Camera: NIDEK AFC-230.
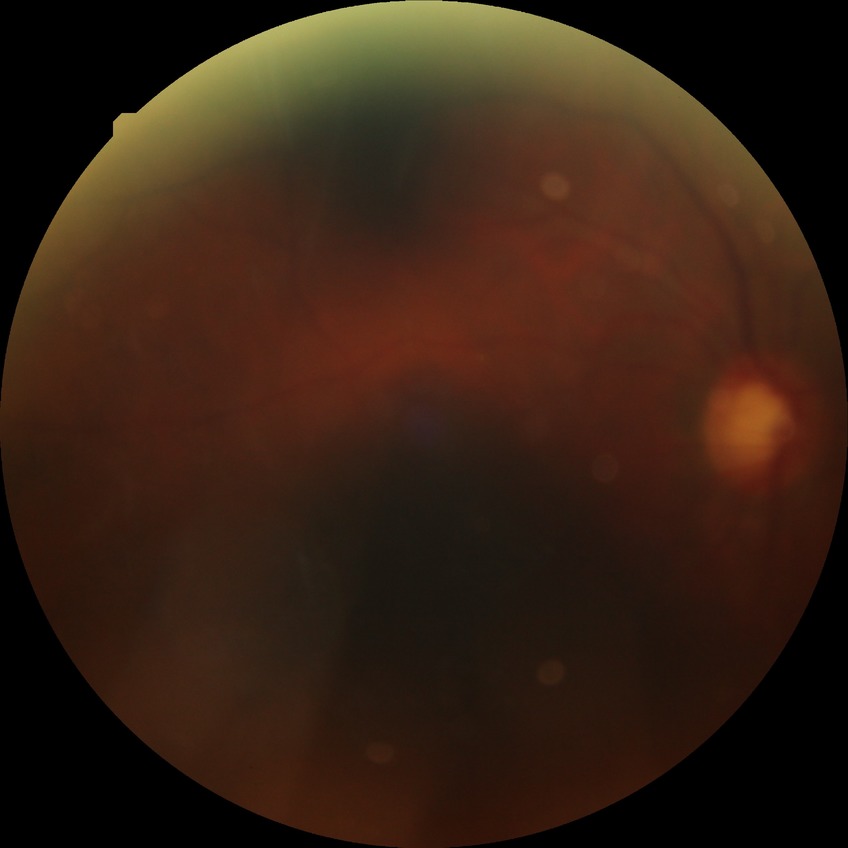 diabetic retinopathy (DR): no diabetic retinopathy (NDR)